Fundus photo — 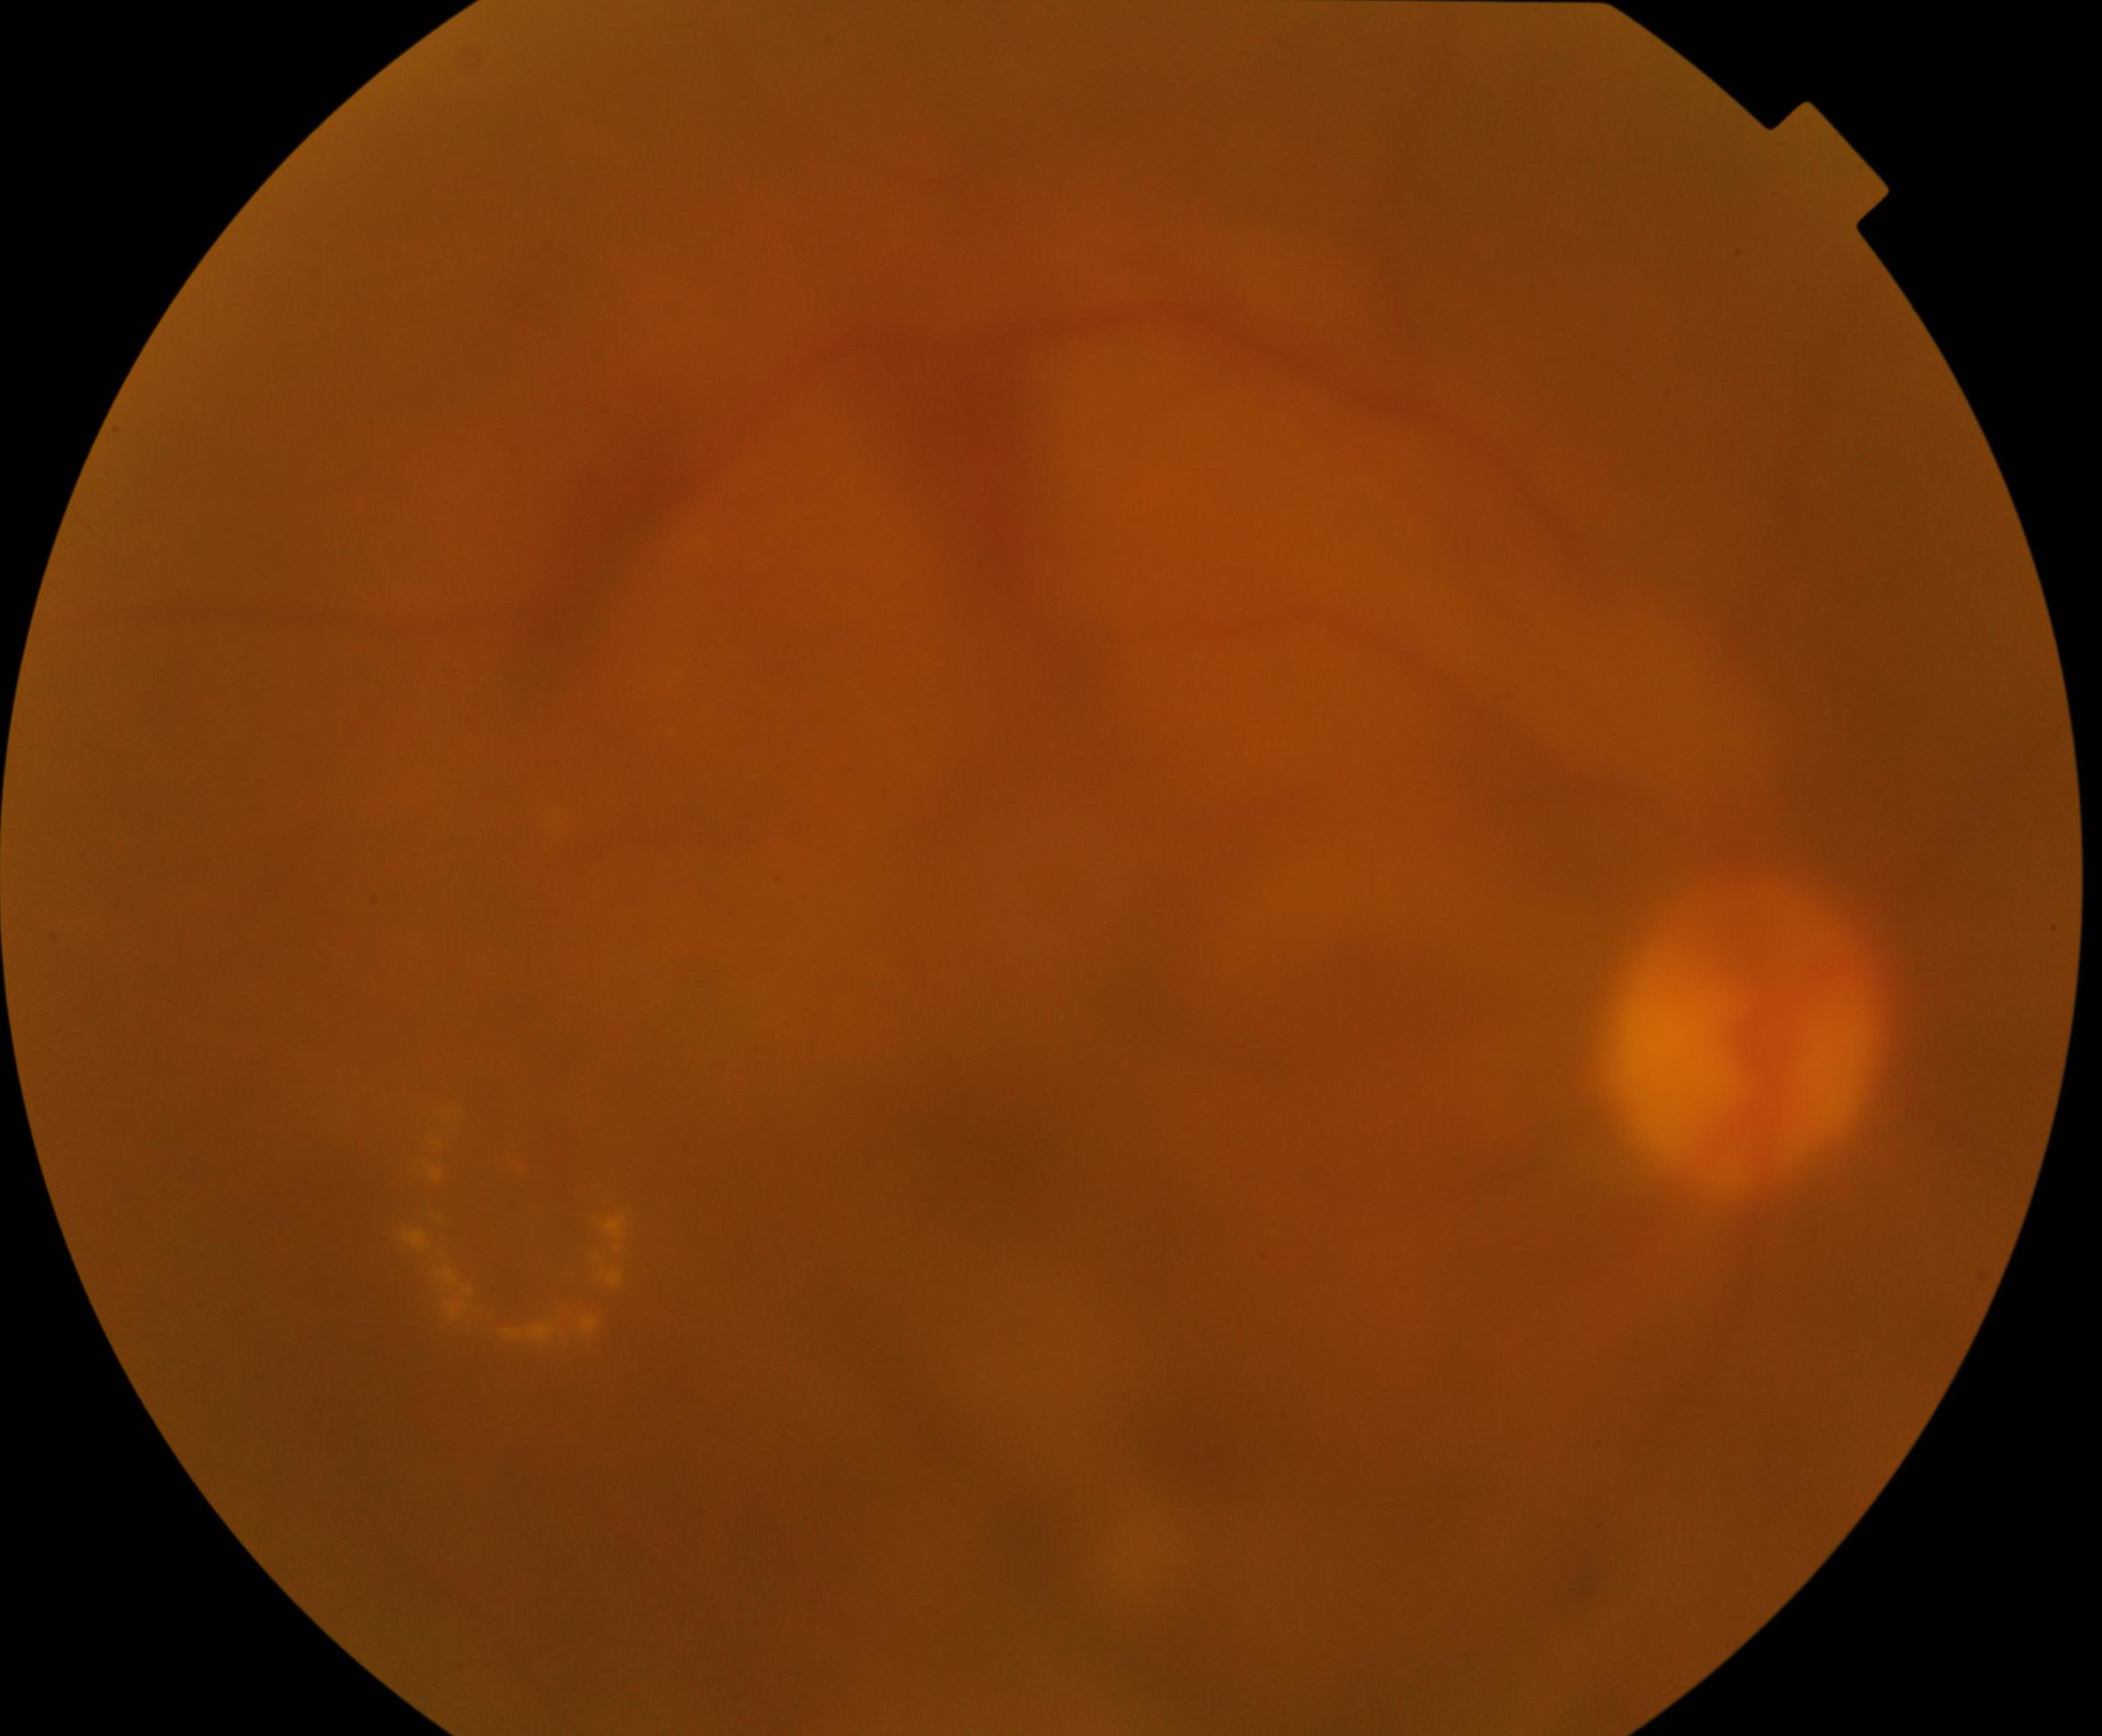

Image quality: poor.
Proliferative diabetic retinopathy: features suspicious.